Retinal fundus photograph — 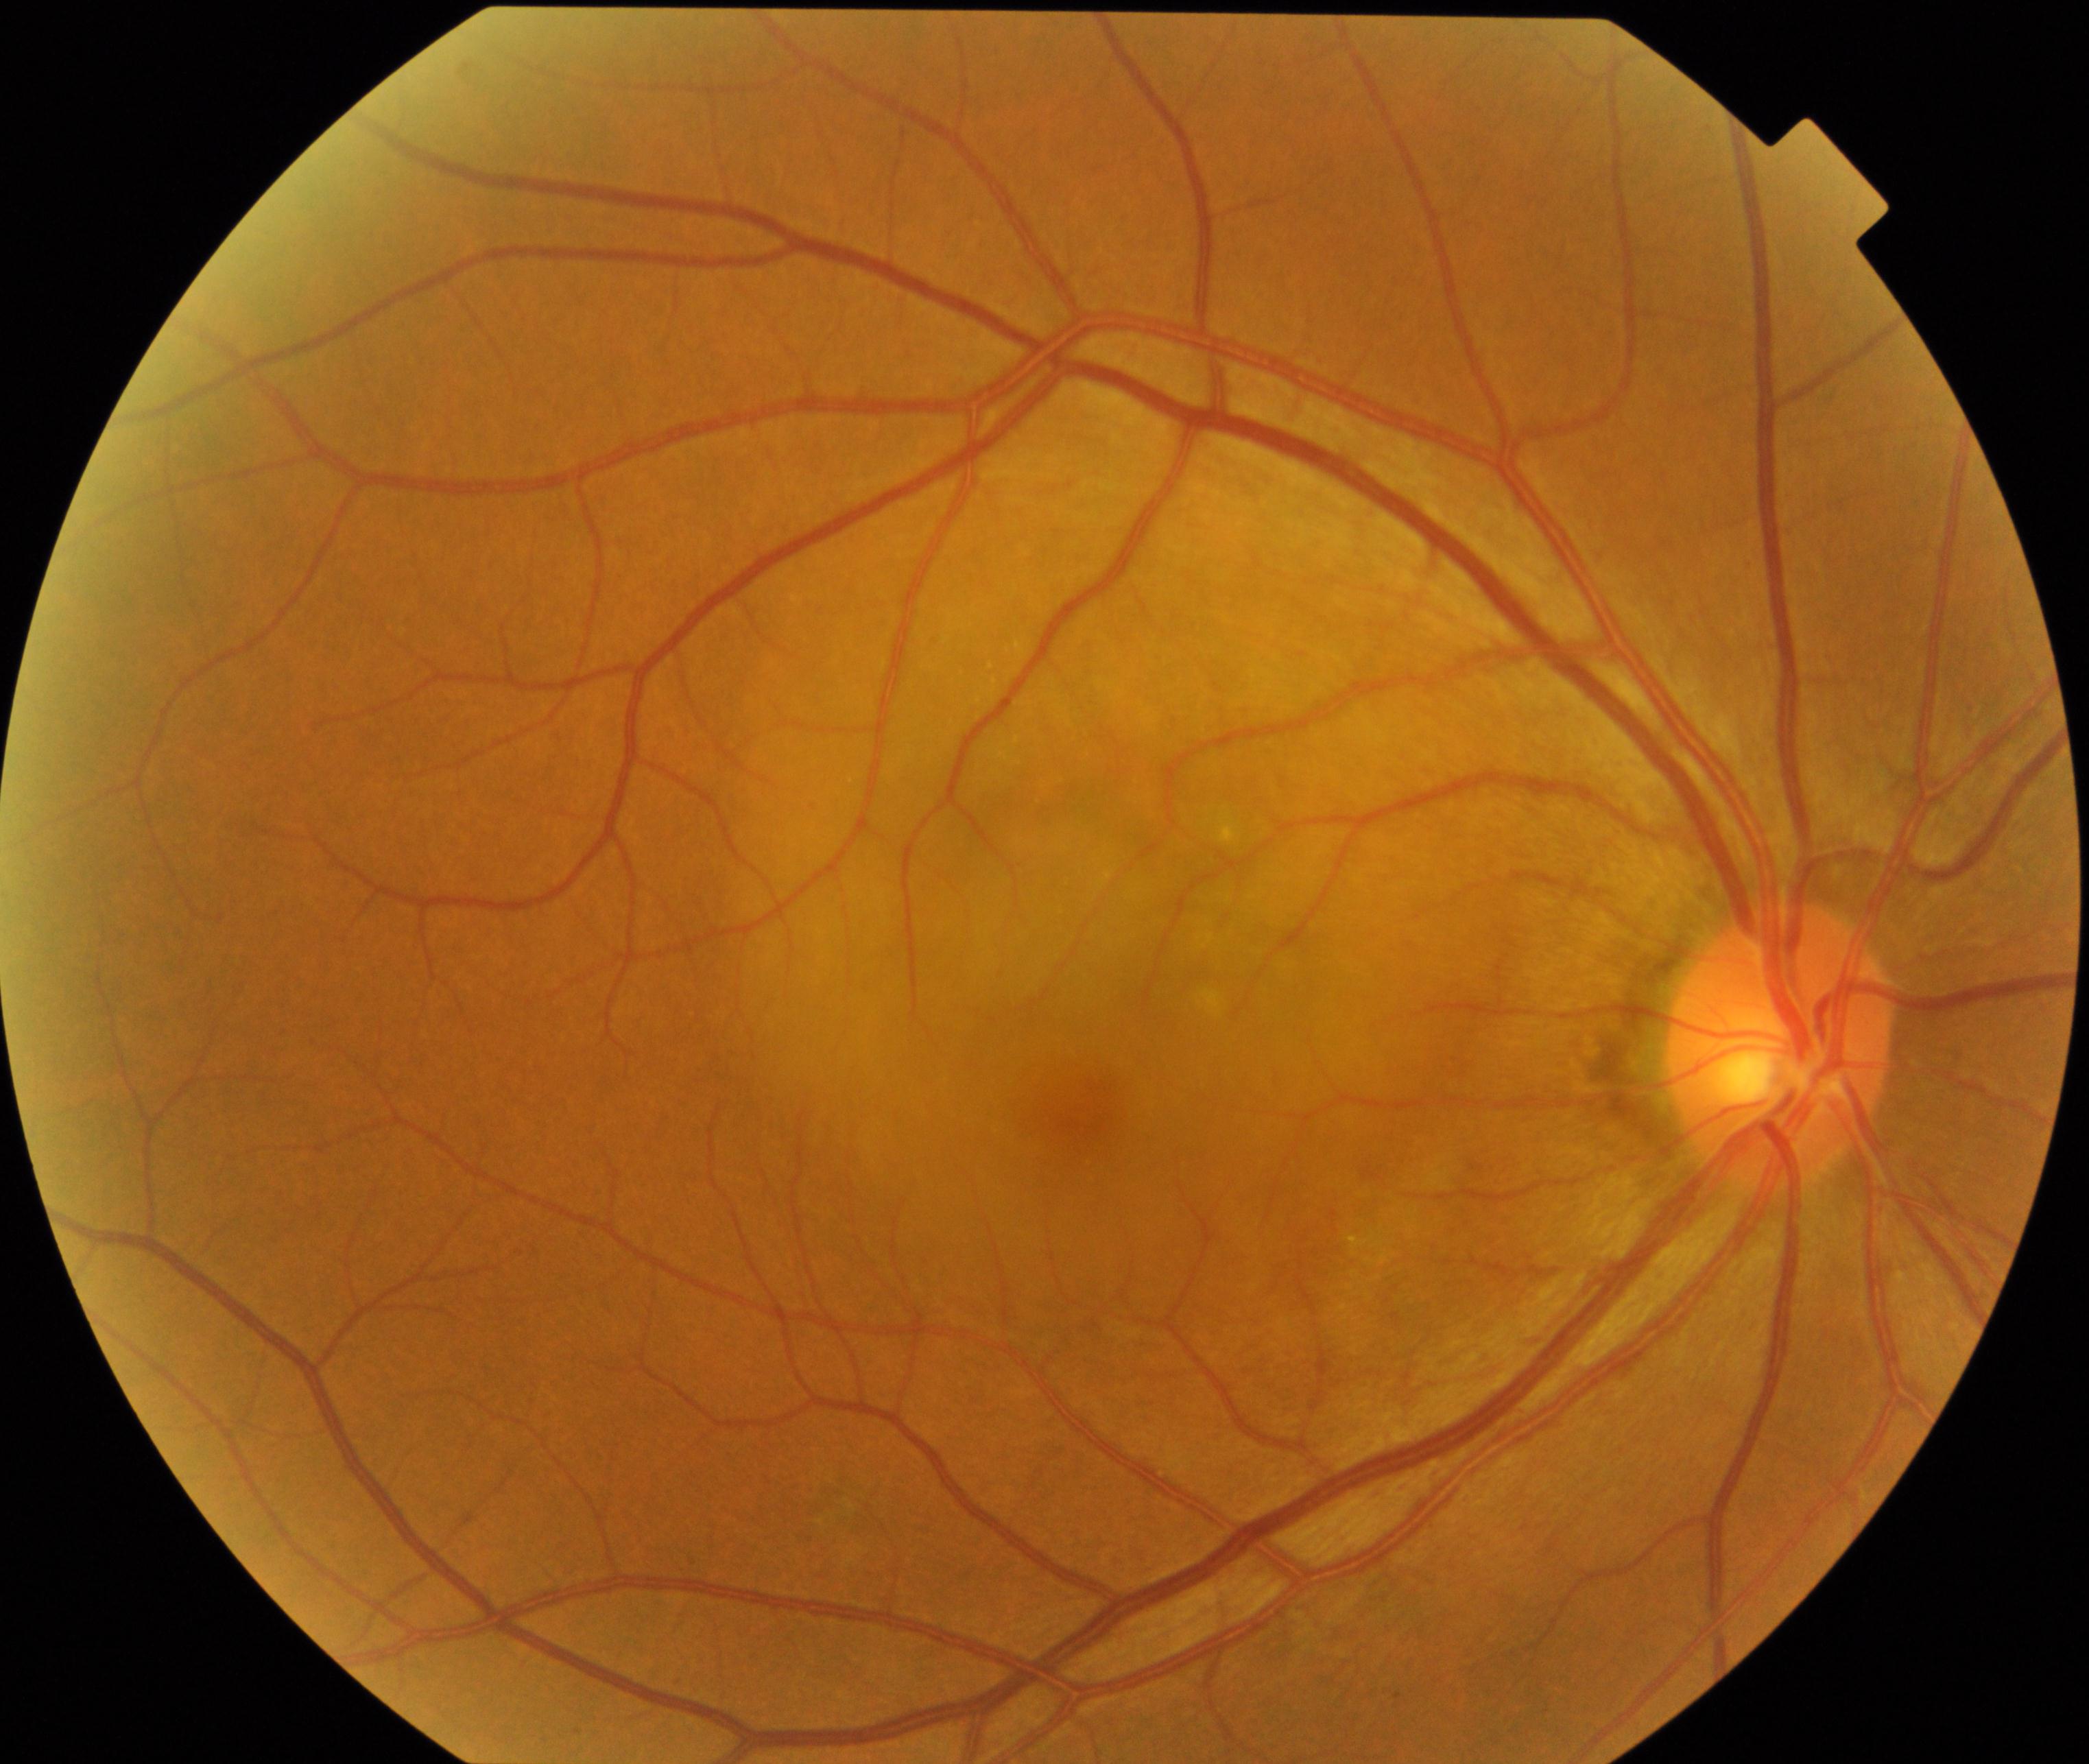
The image shows central serous chorioretinopathy (CSCR).